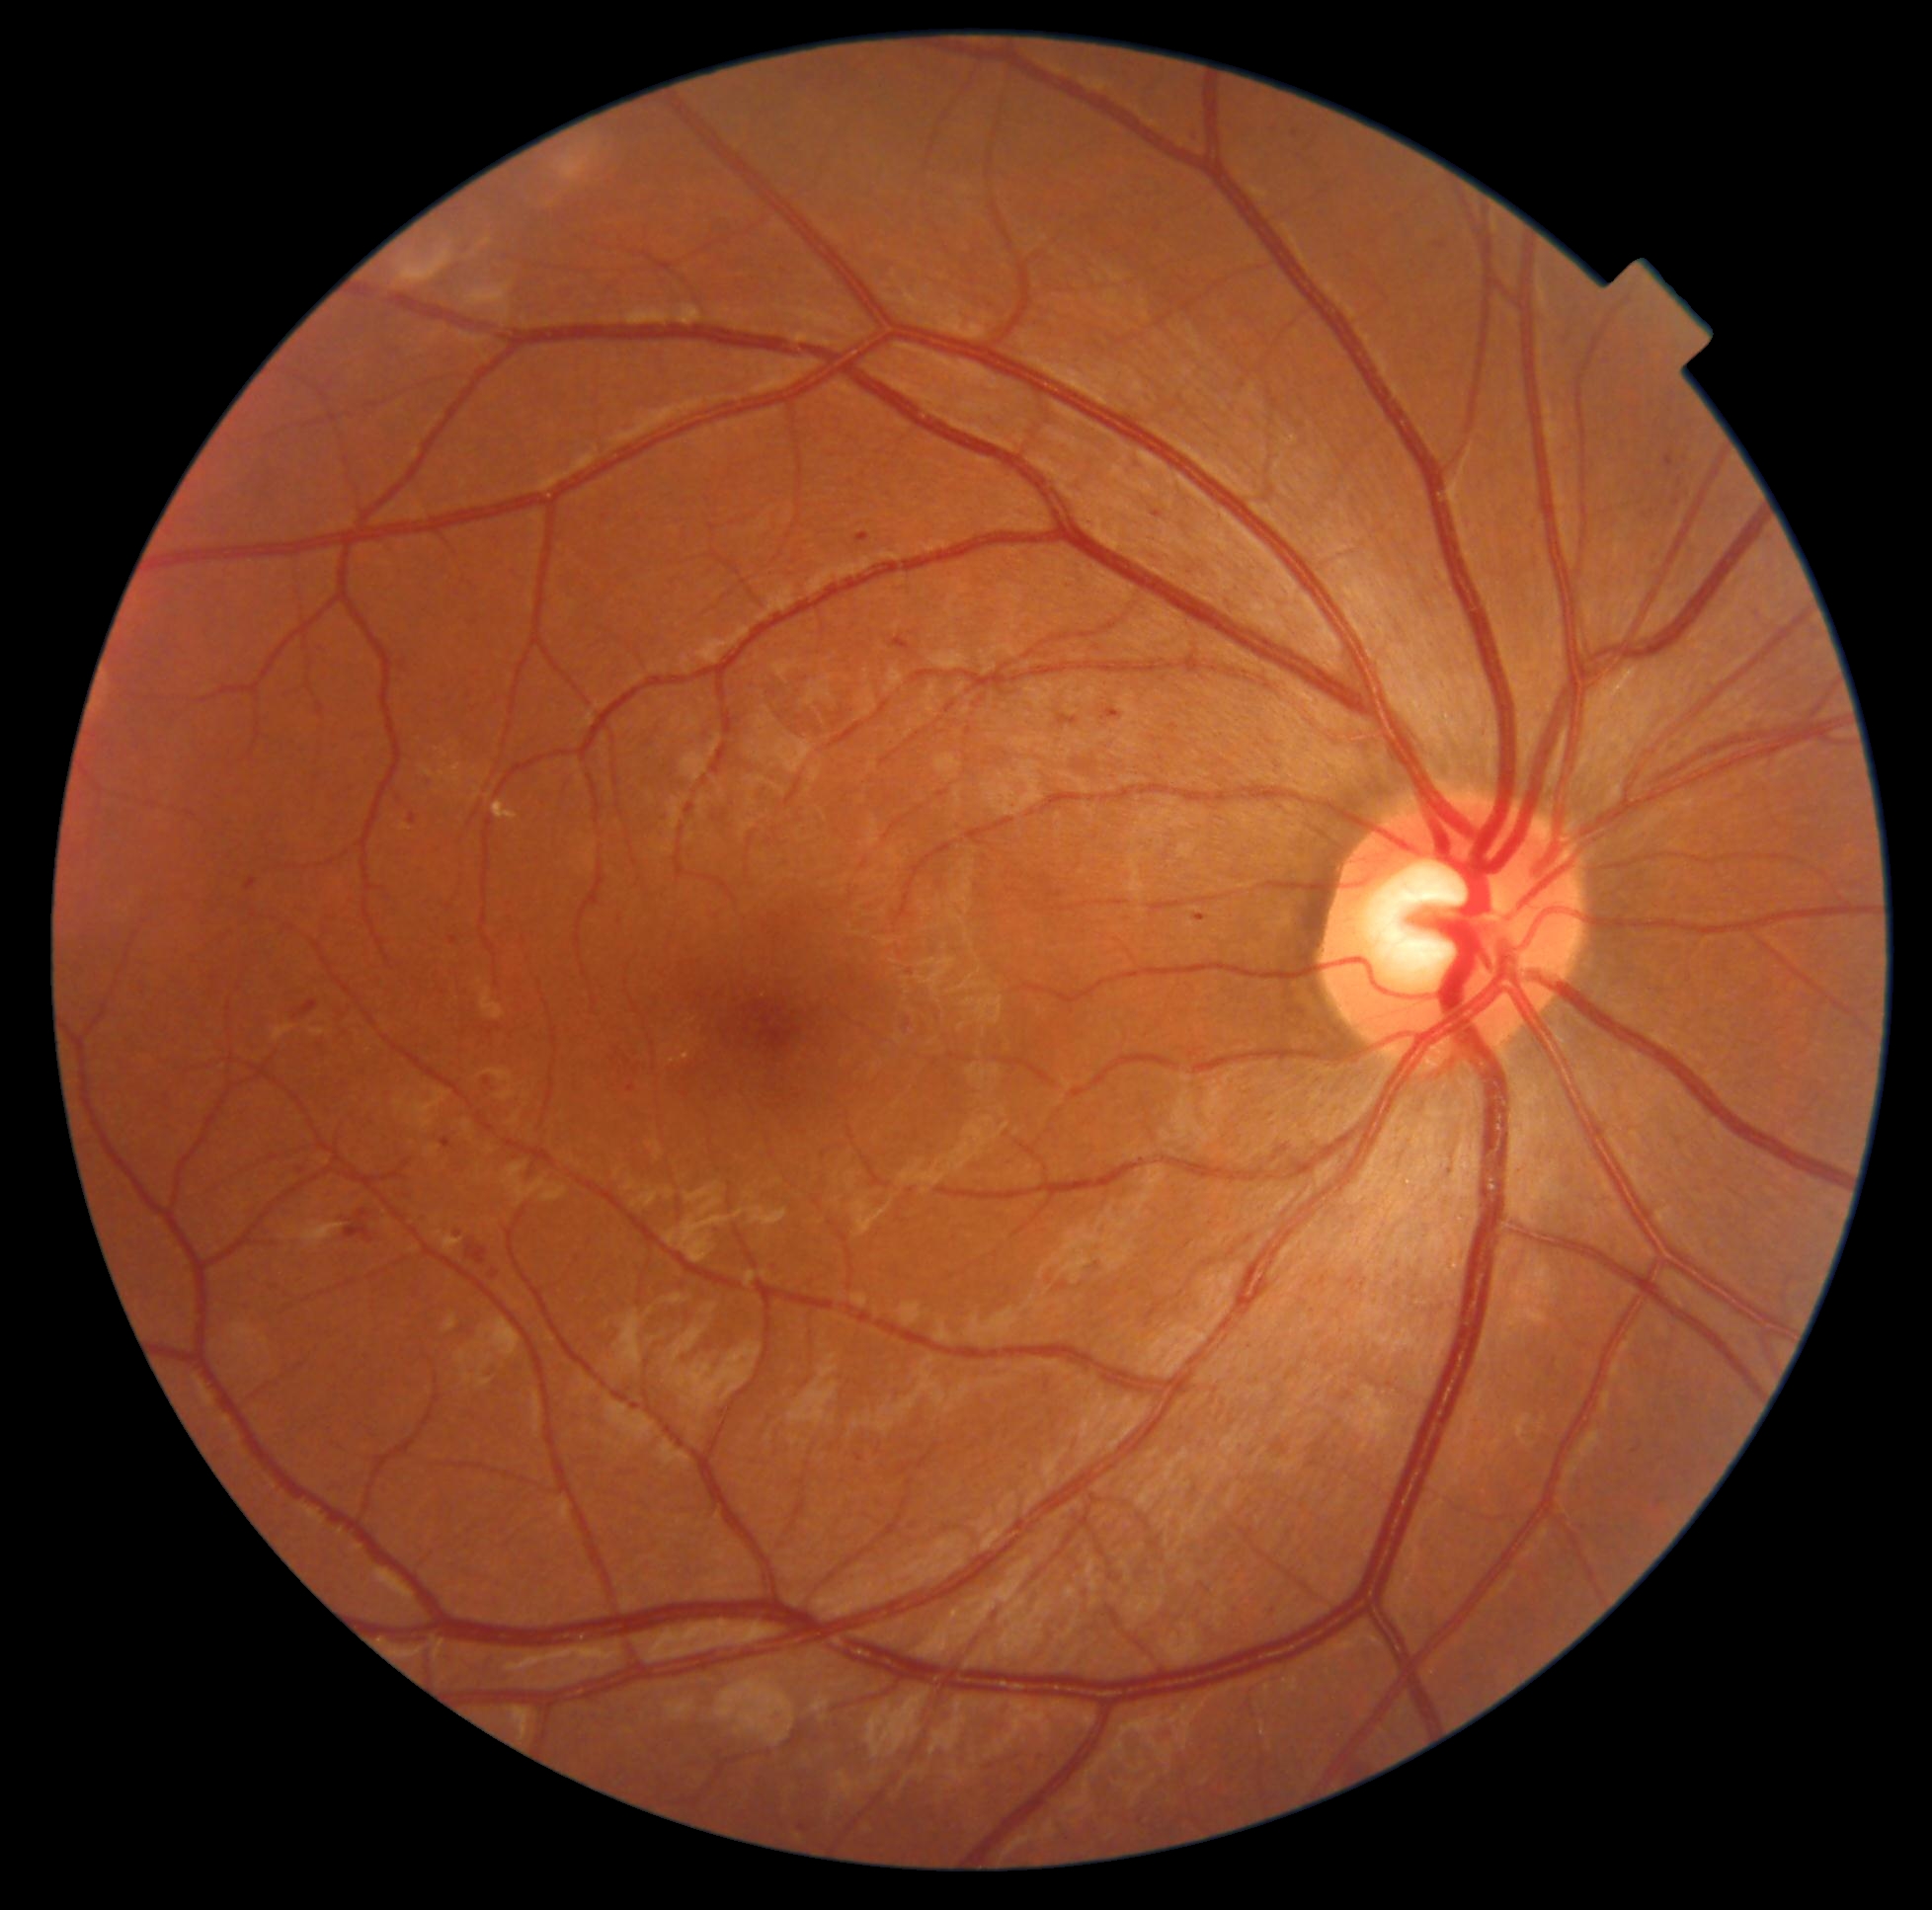

DR: grade 2 (moderate NPDR)
A subset of detected lesions:
EXs: region(493, 801, 520, 823) | region(680, 1054, 690, 1058)
MAs (continued): region(1666, 454, 1675, 468) | region(1190, 130, 1199, 138) | region(1267, 1606, 1274, 1615) | region(443, 1139, 451, 1150) | region(1679, 479, 1689, 488) | region(408, 815, 417, 828) | region(800, 1825, 809, 1834) | region(627, 1086, 636, 1093) | region(246, 878, 257, 891) | region(1059, 716, 1079, 726)
Small MAs approximately at Point(488, 1082) | Point(1441, 247) | Point(1677, 504)
HEs: region(346, 1211, 375, 1244) | region(291, 1000, 318, 1023) | region(892, 637, 912, 652) | region(465, 1242, 489, 1266)
SEs: none identified